2352 x 1568 pixels:
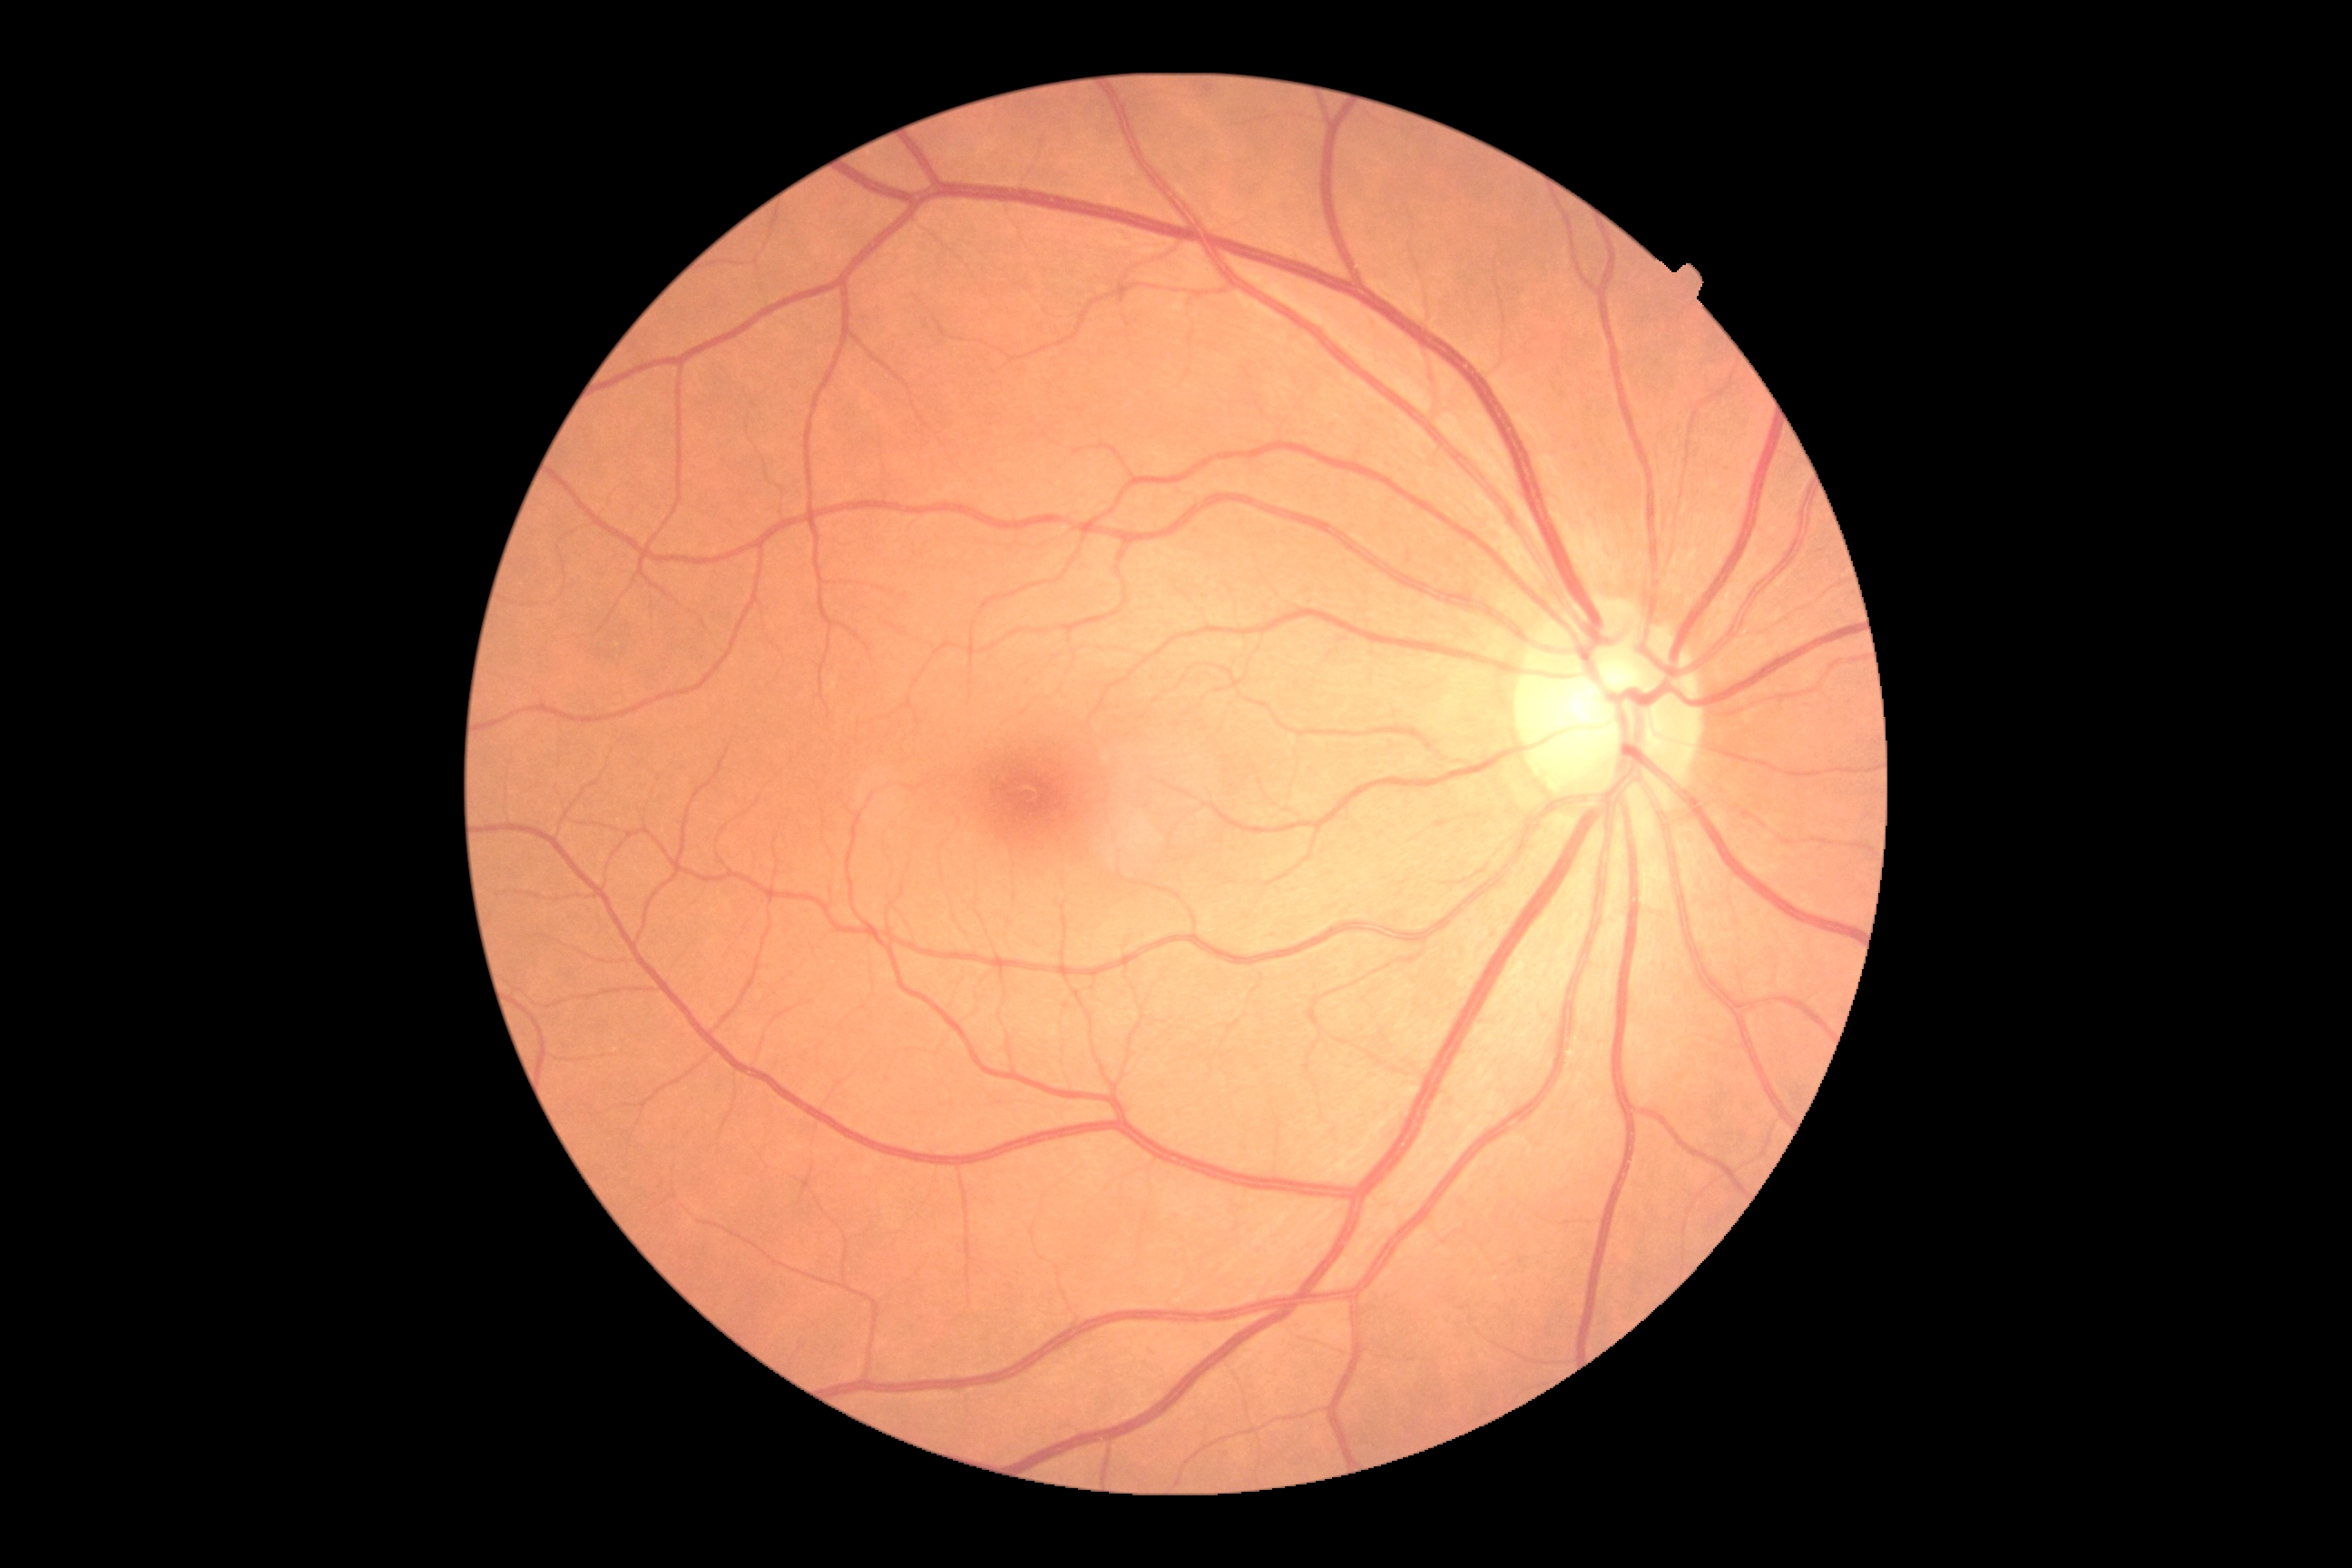

DR stage is 0.